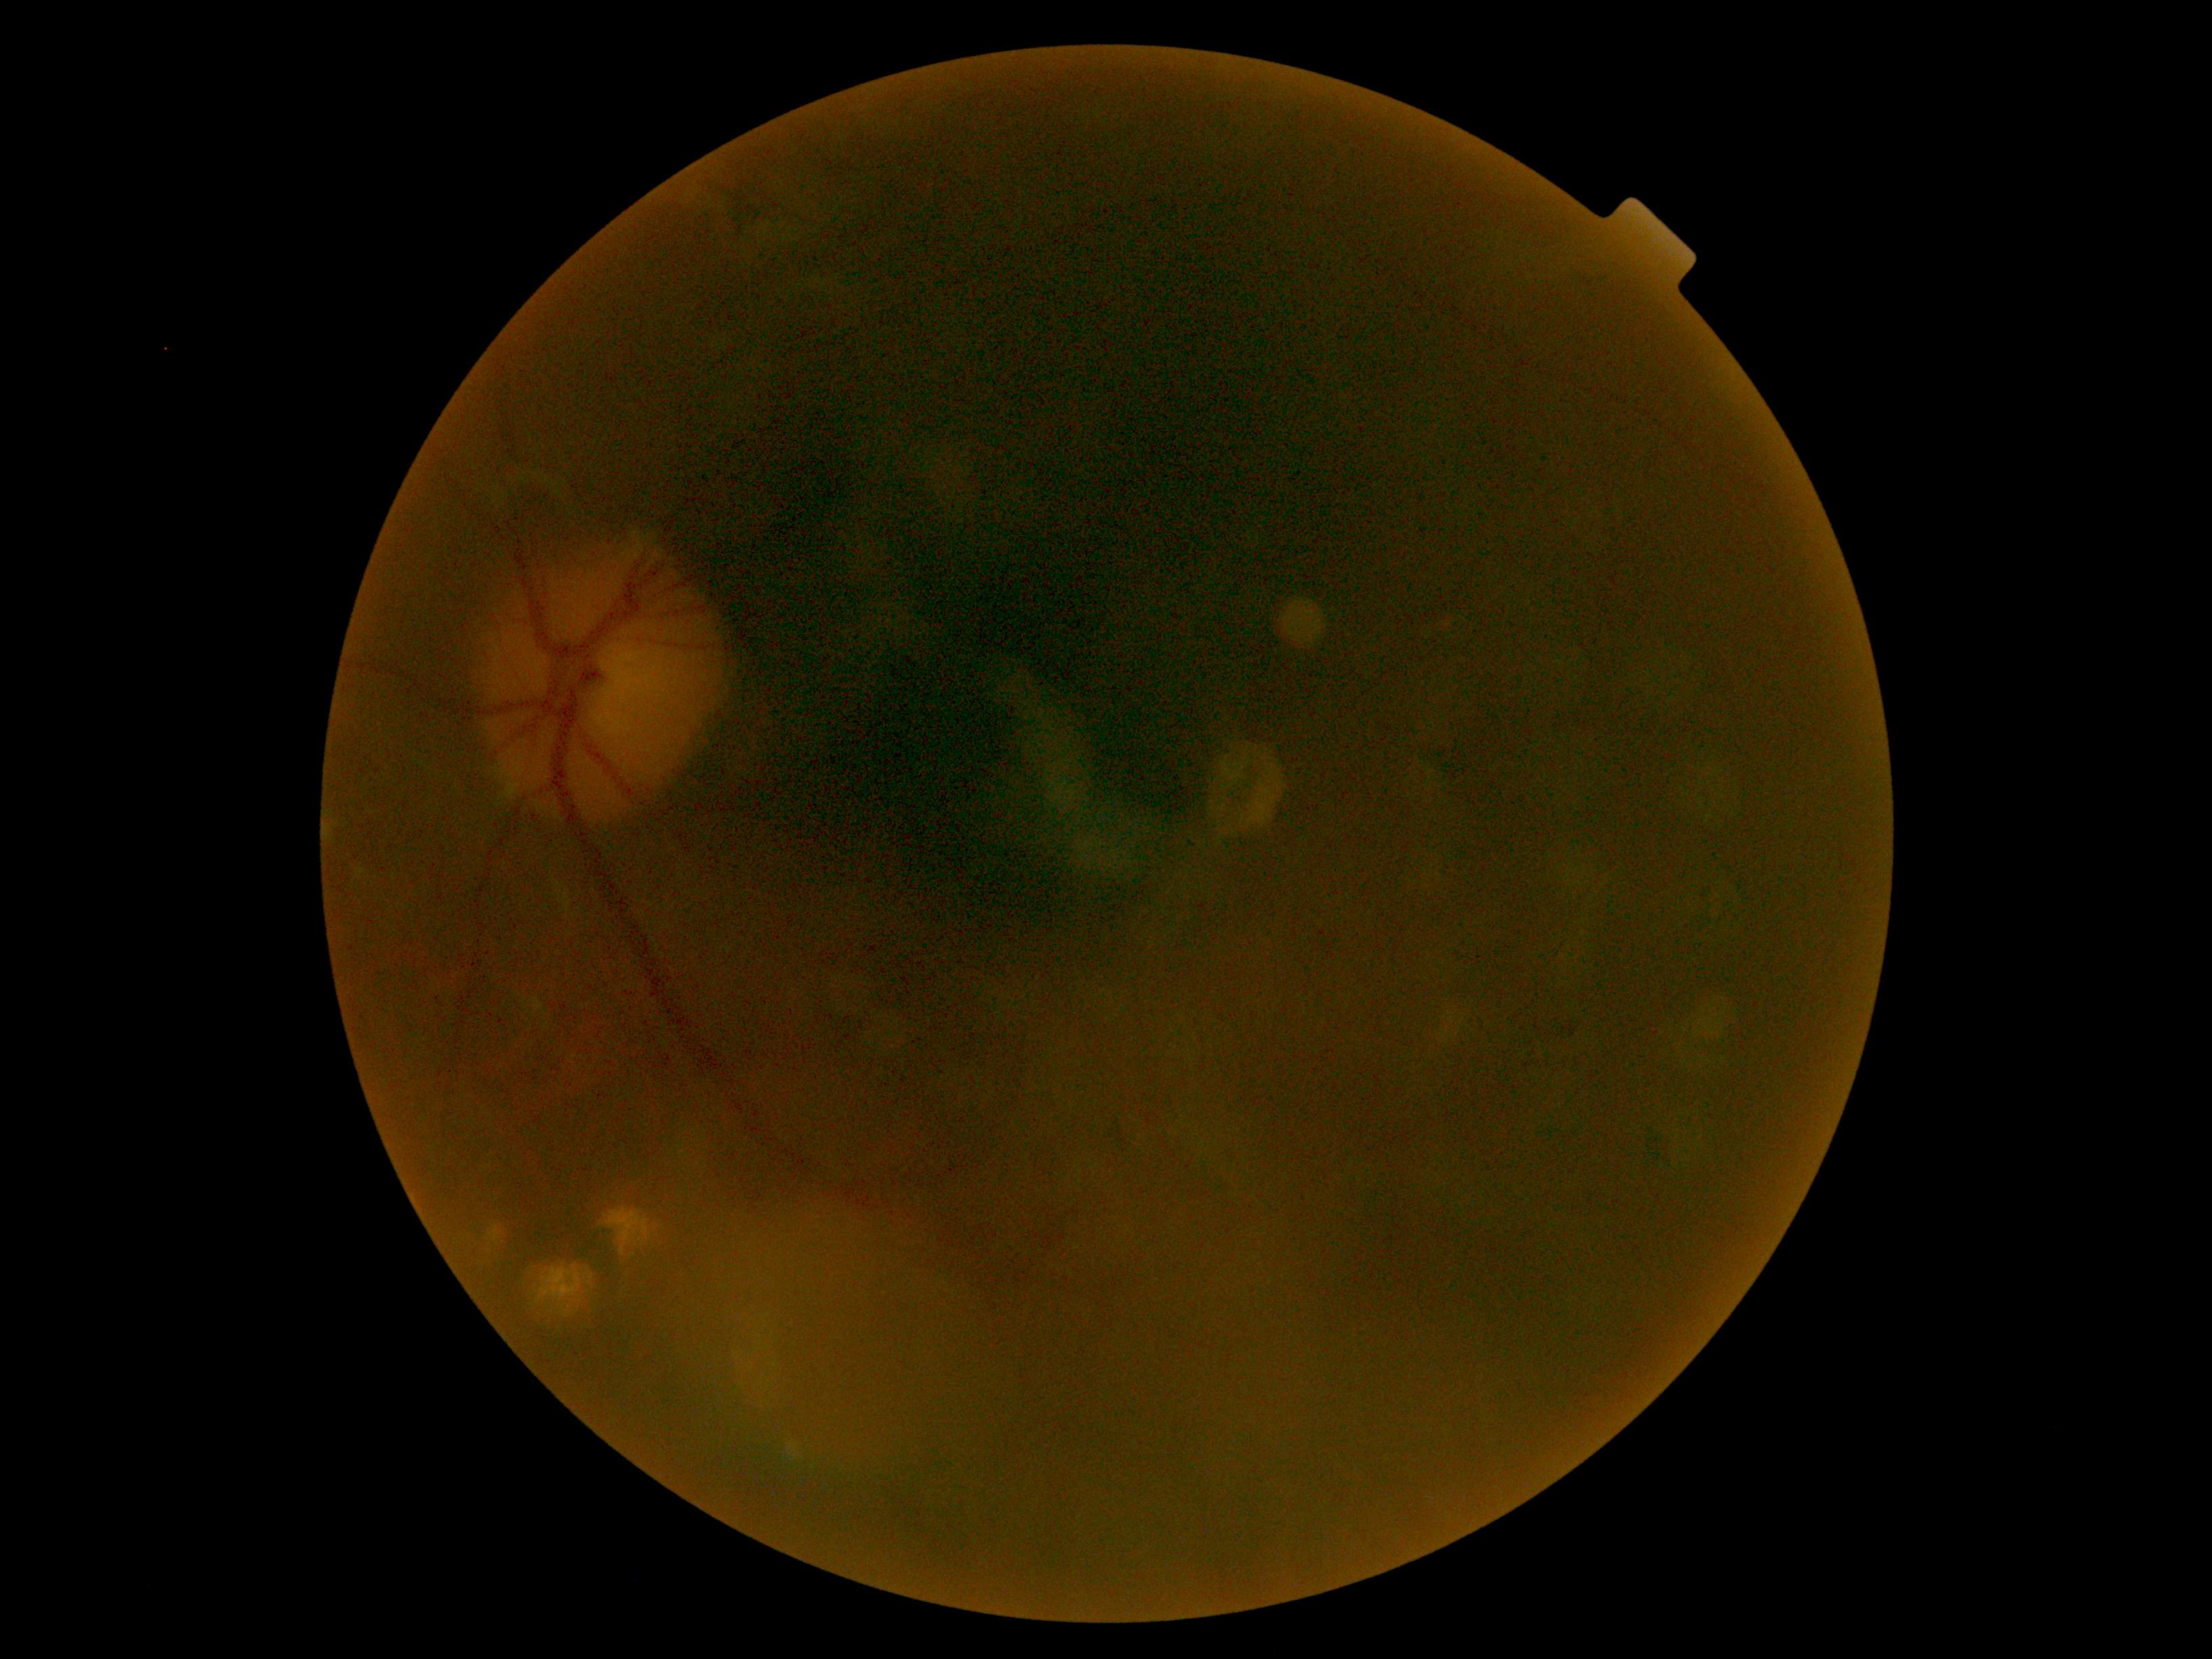

diabetic retinopathy grade = 0 (no apparent retinopathy).